130° field of view (Clarity RetCam 3); infant wide-field retinal image; 640x480.
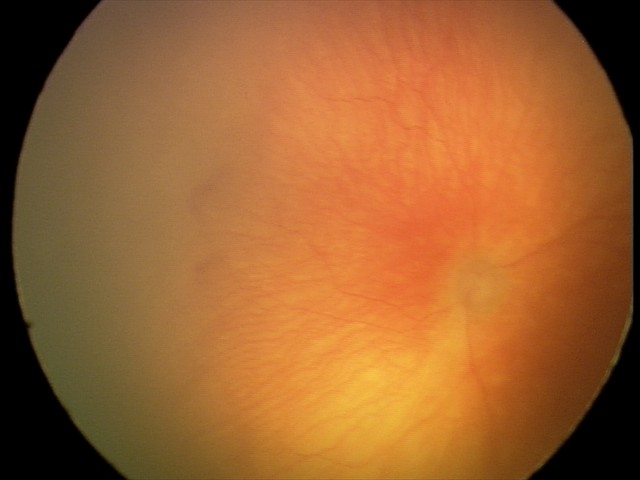 Diagnosis from this screening exam: aggressive ROP (A-ROP).
With plus disease.